Image size 848x848
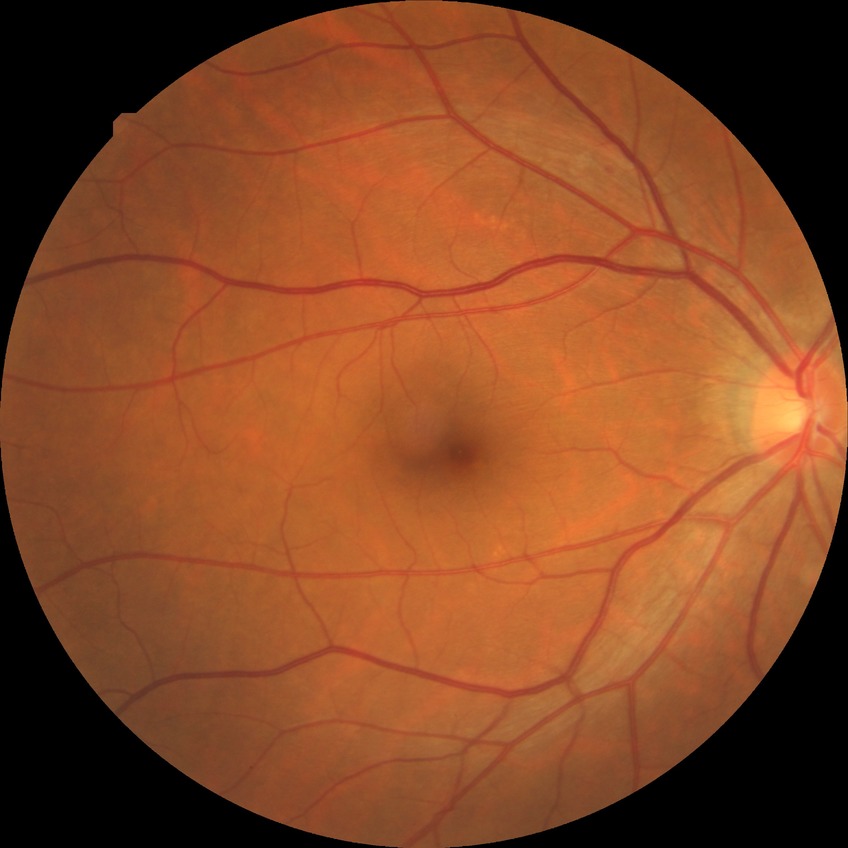 DR stage: NDR.